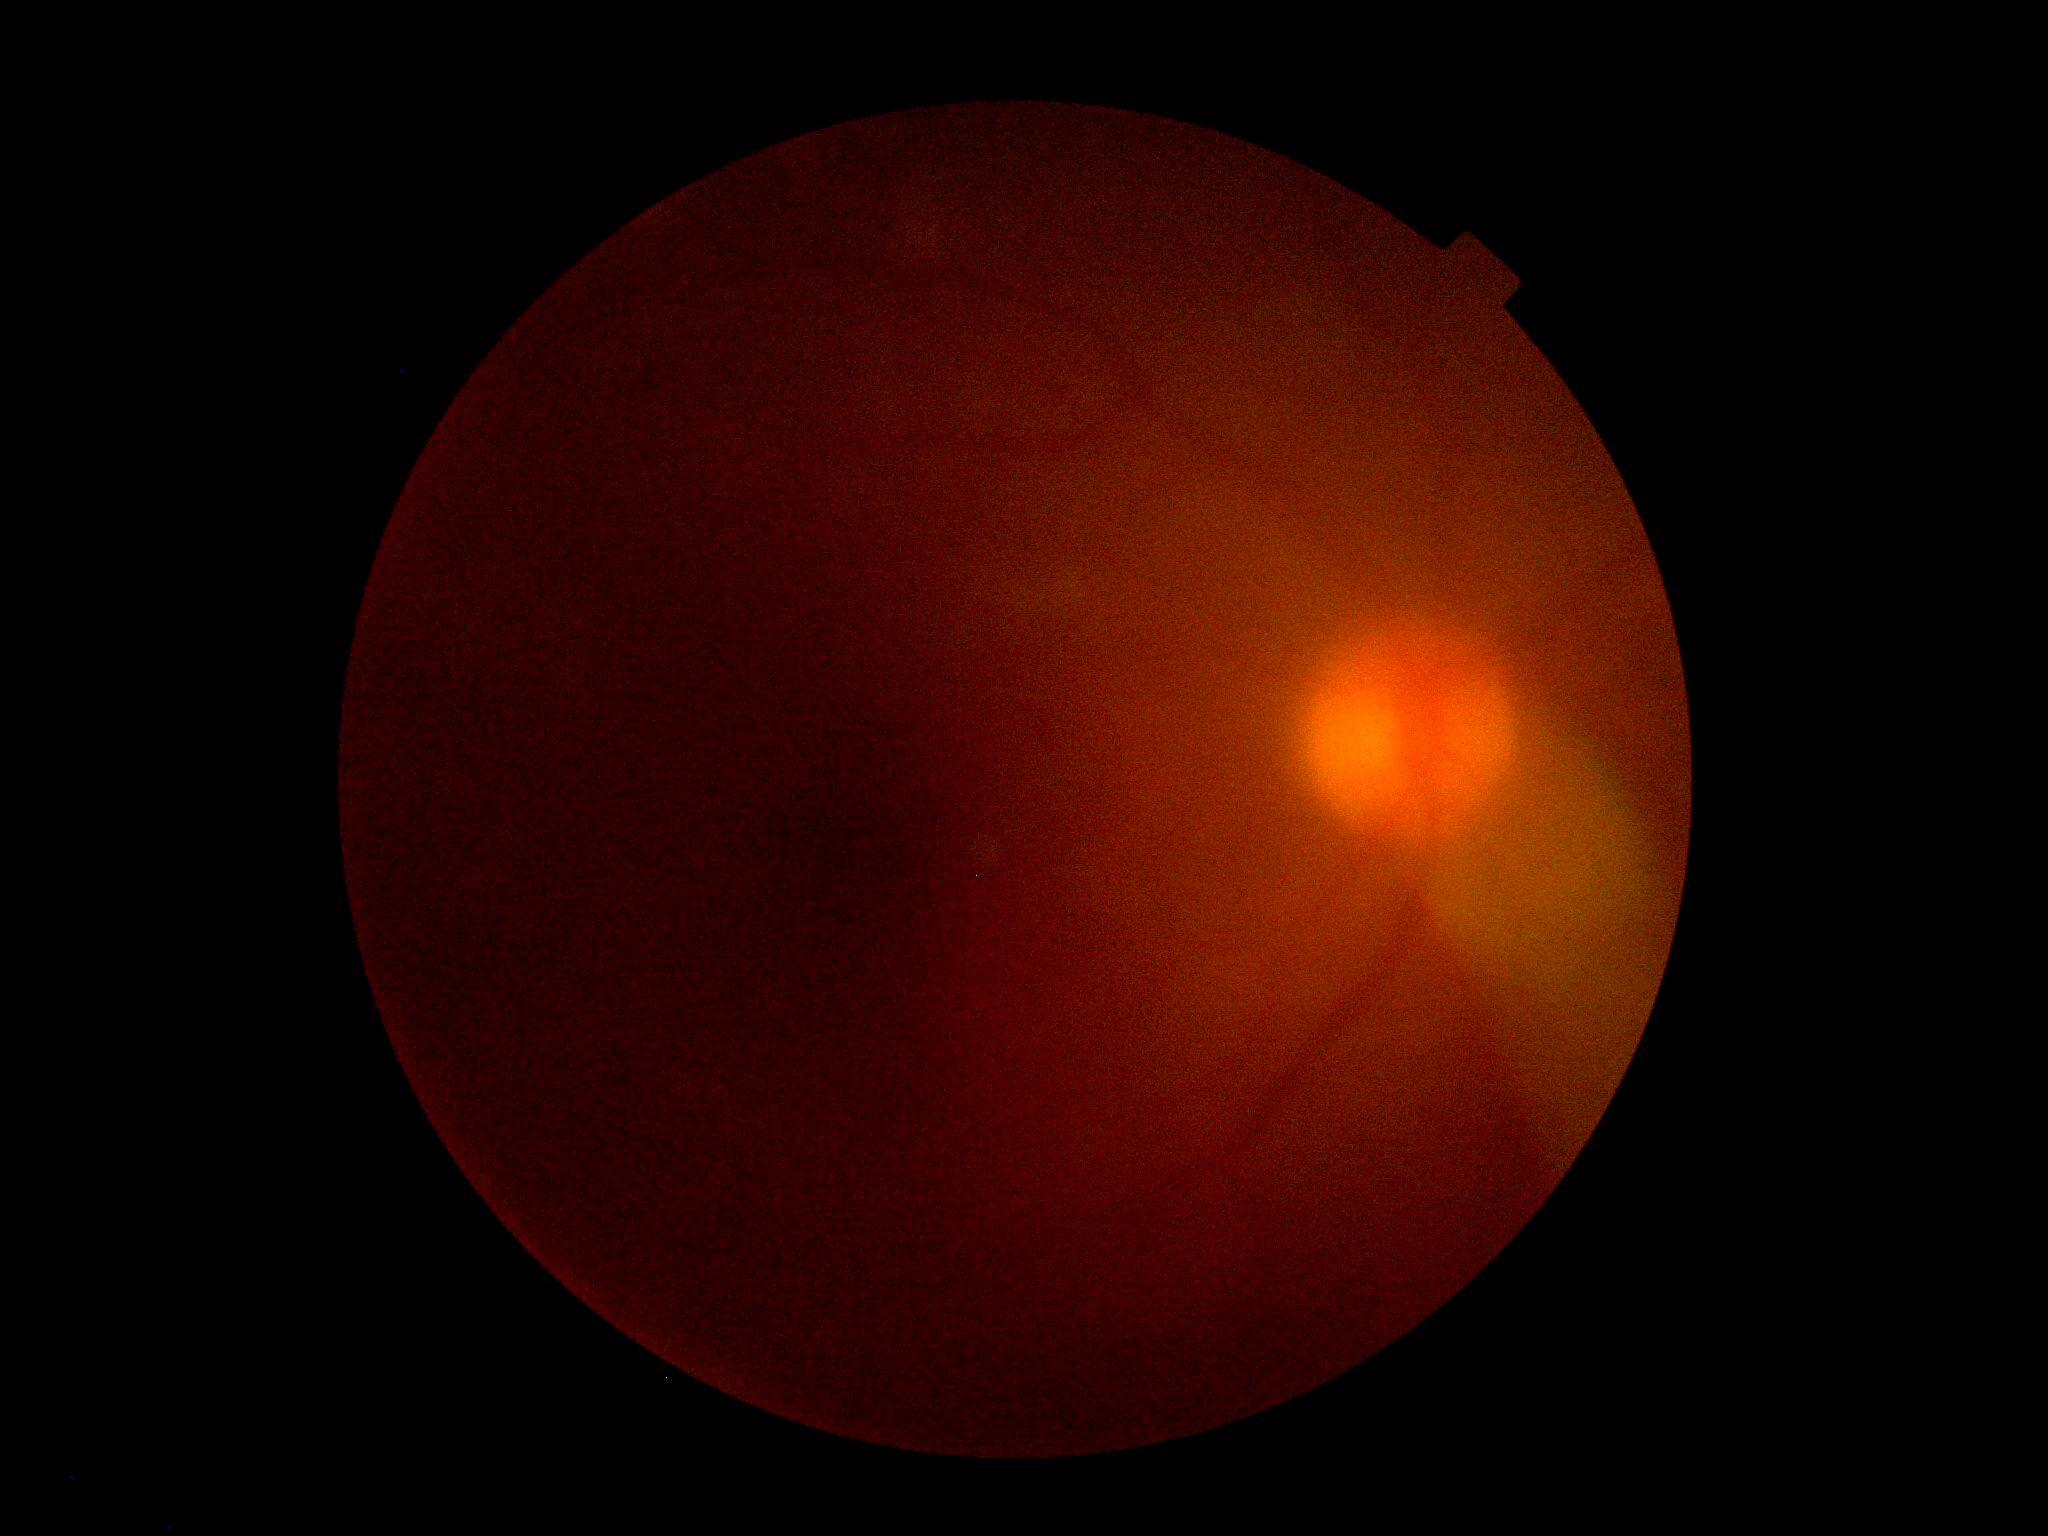

Retinopathy grade: ungradable due to poor image quality.